1932x1916px. CFP: 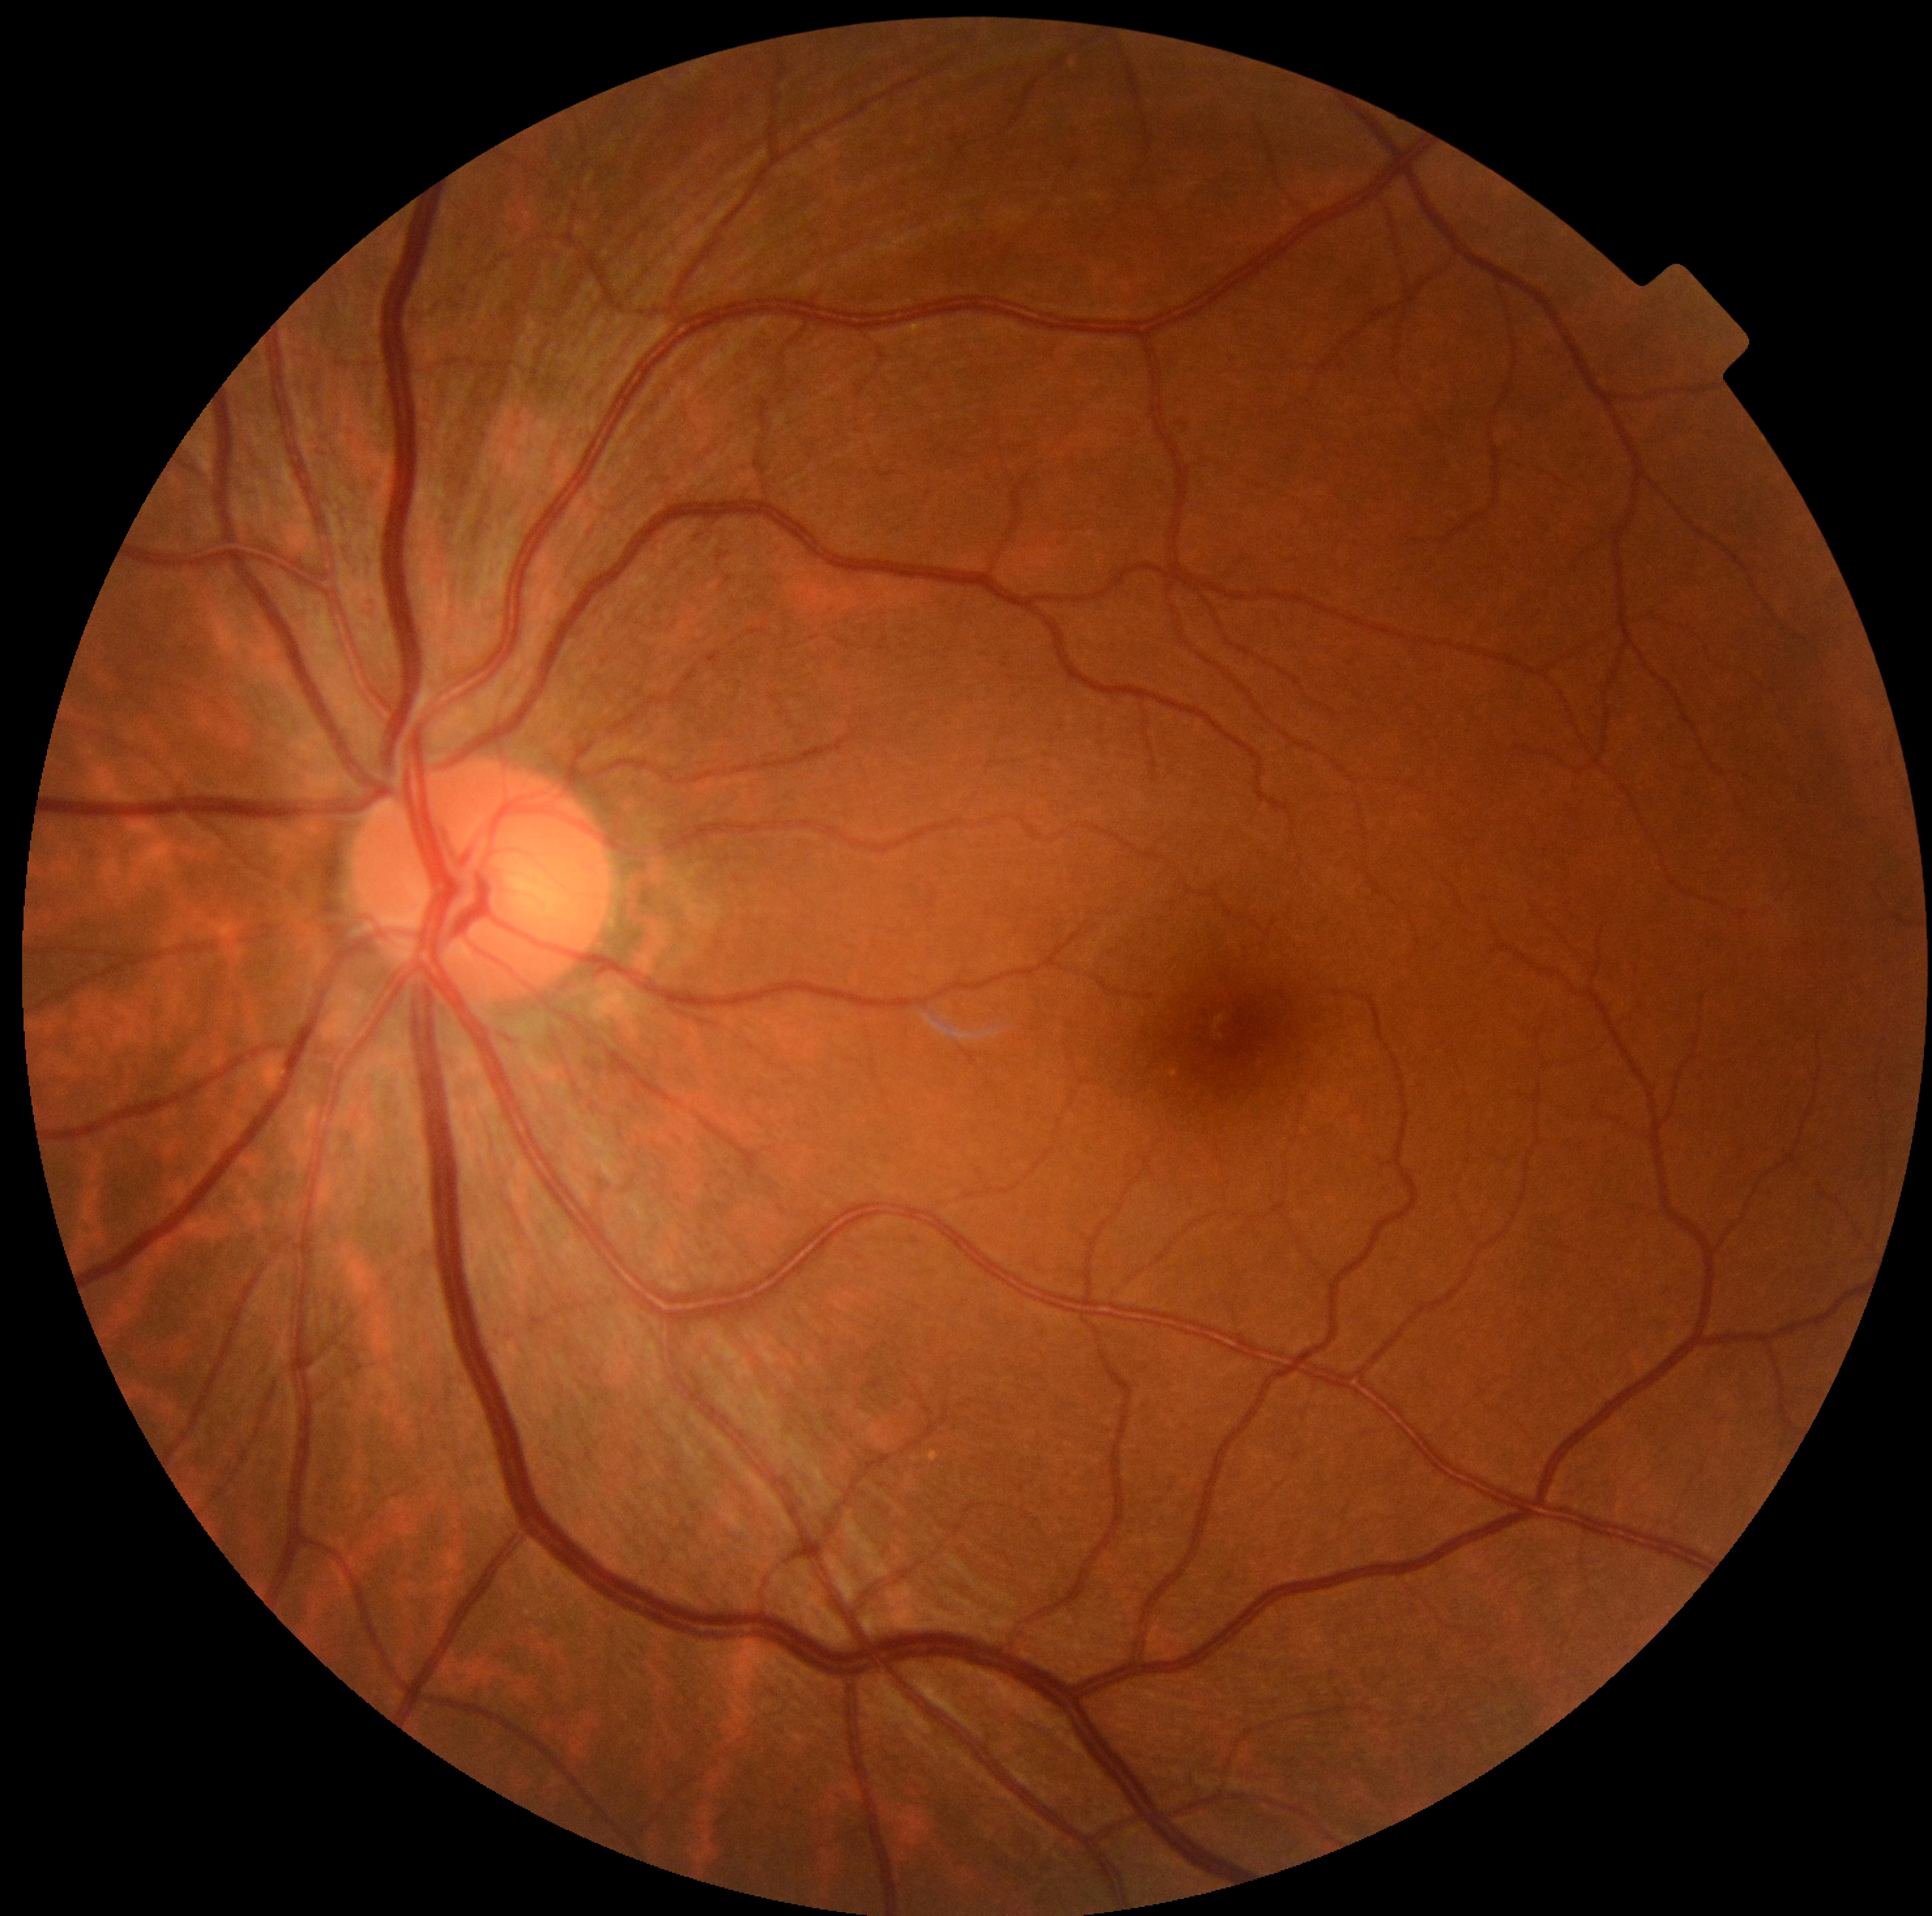

DR severity: grade 0 — no visible signs of diabetic retinopathy.